No pharmacologic dilation. 45° FOV. 848 x 848 pixels. Posterior pole color fundus photograph. Camera: NIDEK AFC-230.
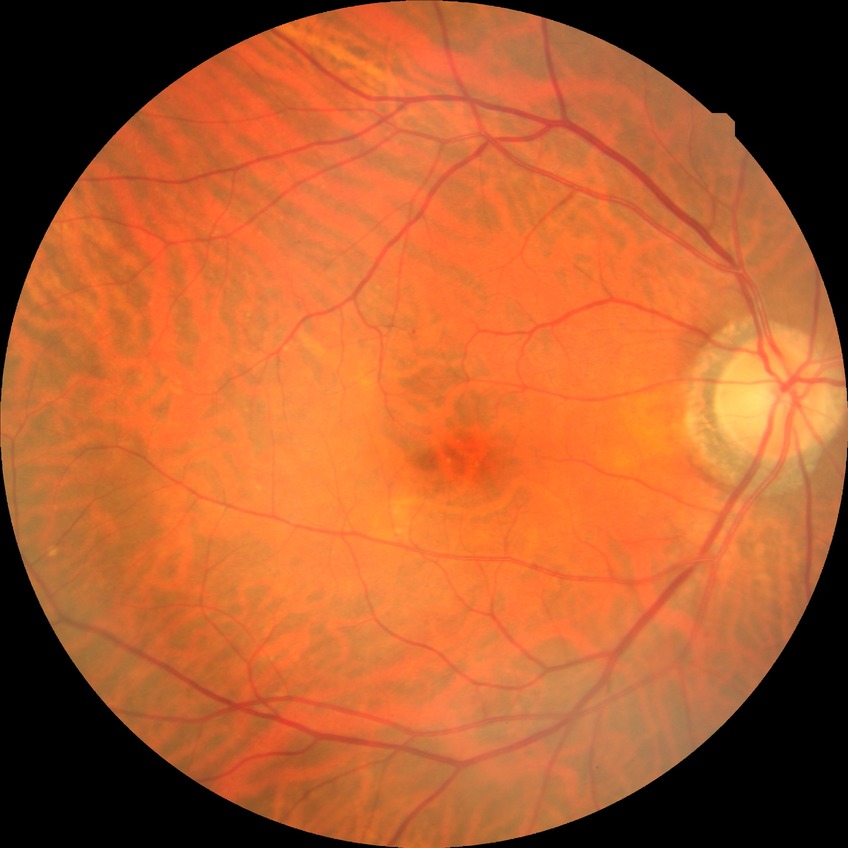

diabetic retinopathy (DR): NDR (no diabetic retinopathy).